CFP; 45-degree field of view; acquired with a NIDEK AFC-230: 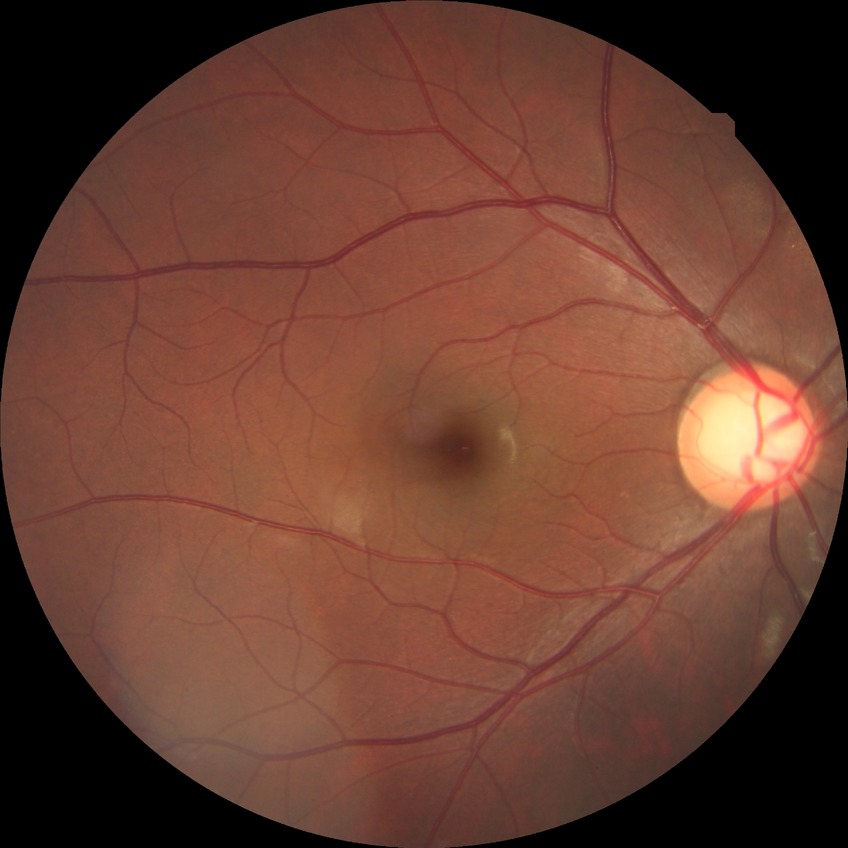 Davis grading is no diabetic retinopathy.